45° FOV; no pharmacologic dilation:
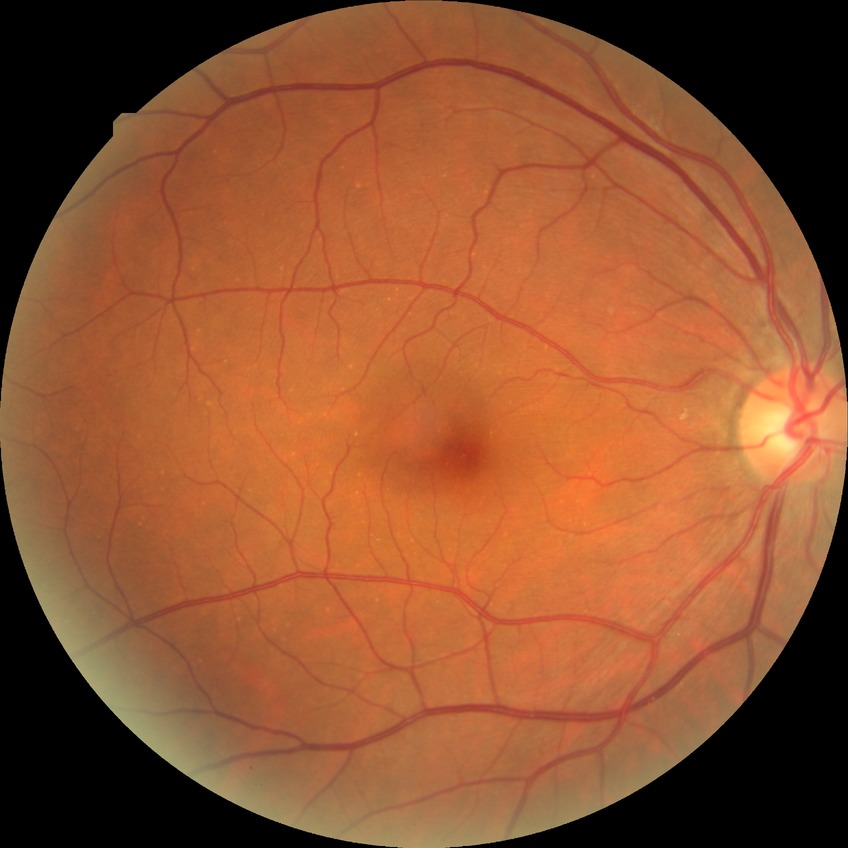
Davis grading is no diabetic retinopathy.